Wide-field contact fundus photograph of an infant; 640 by 480 pixels — 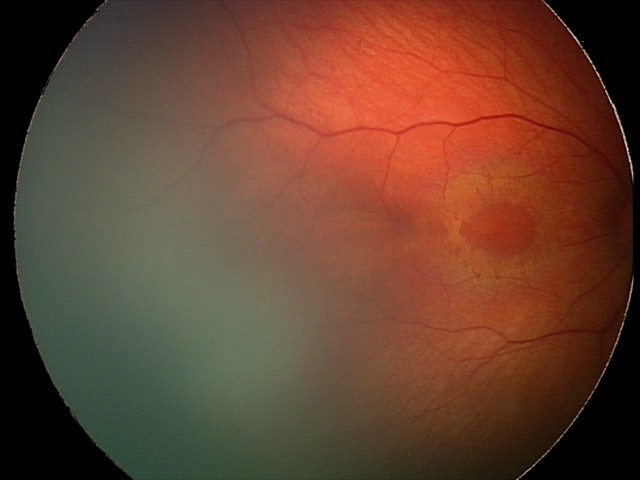

Q: What is the screening diagnosis?
A: retinal hemorrhages